2352 by 1568 pixels. Retinal fundus photograph — 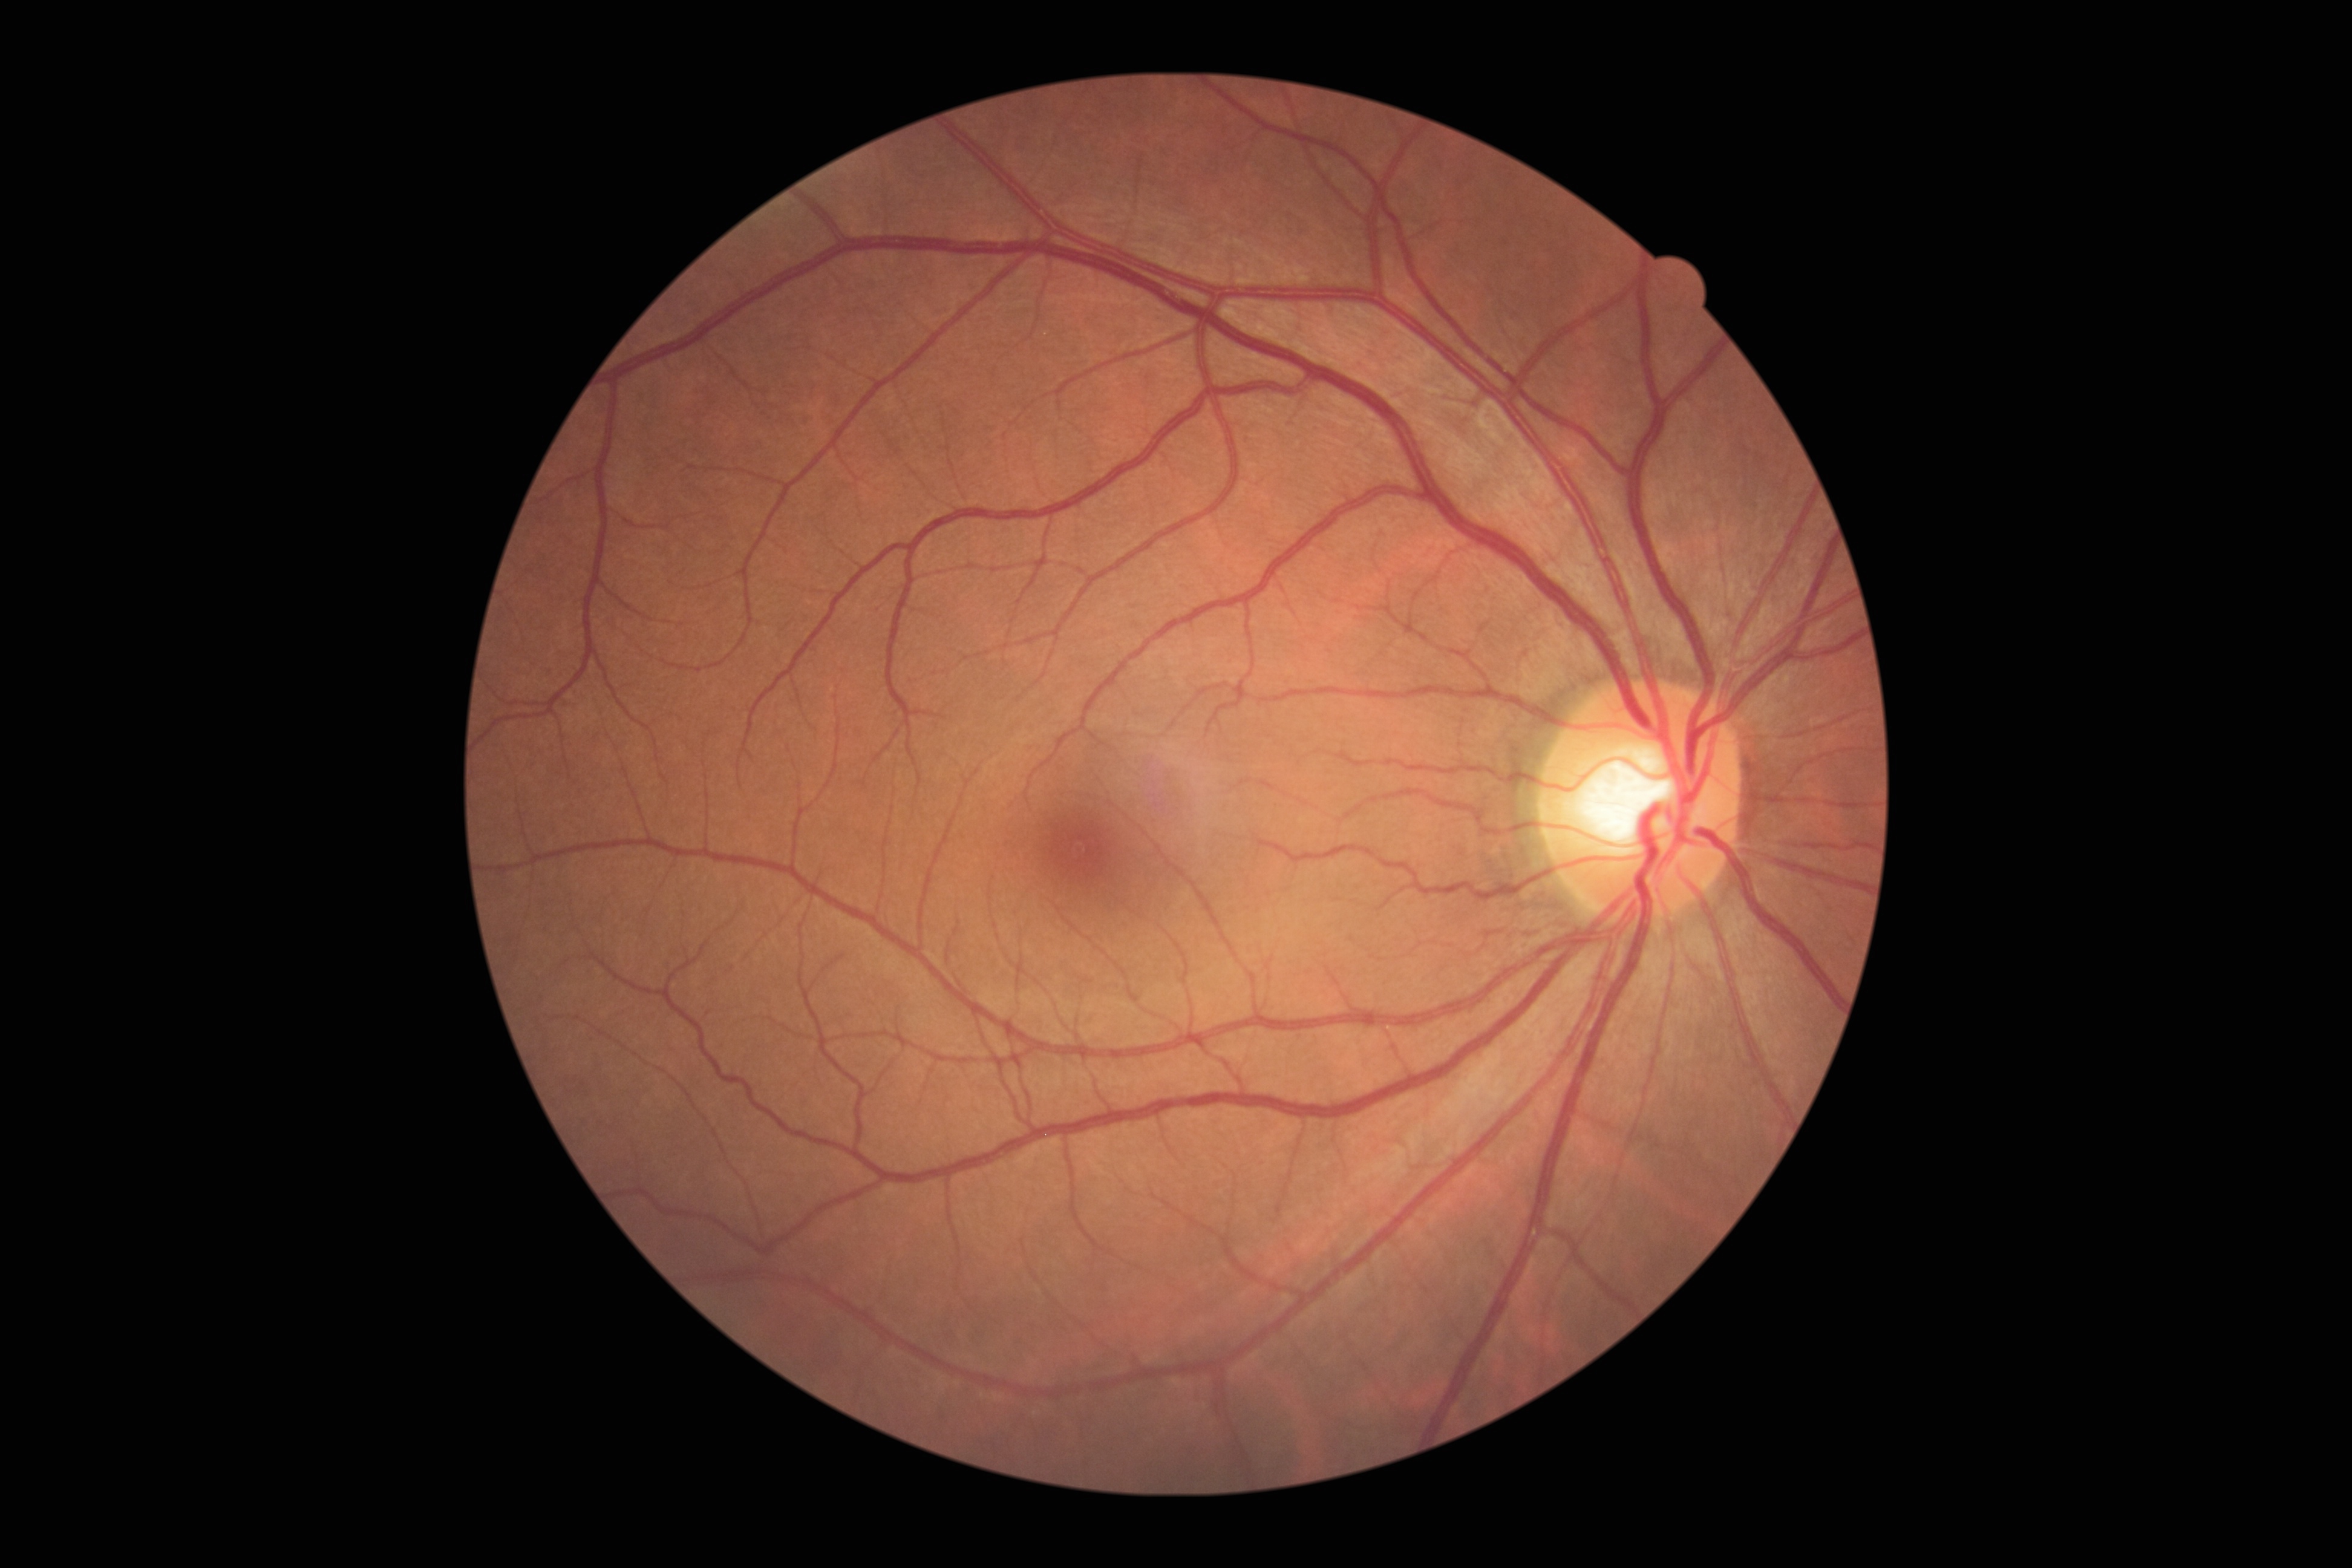
No diabetic retinal disease findings. Diabetic retinopathy grade is no apparent diabetic retinopathy (0).